640 x 480 pixels · camera: Clarity RetCam 3 (130° FOV) · wide-field contact fundus photograph of an infant — 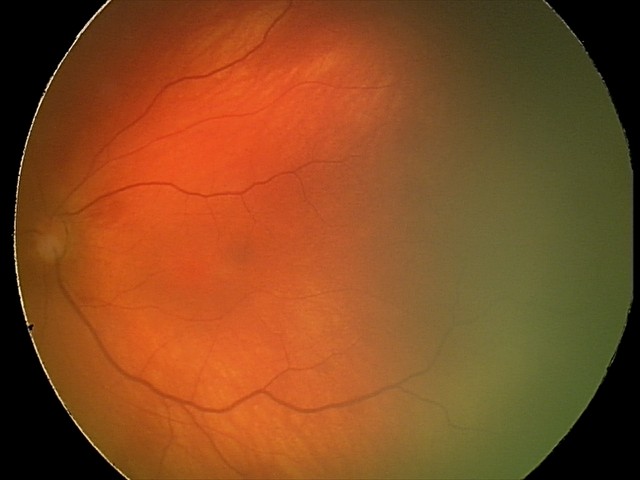 Series diagnosed as retinal hemorrhages.